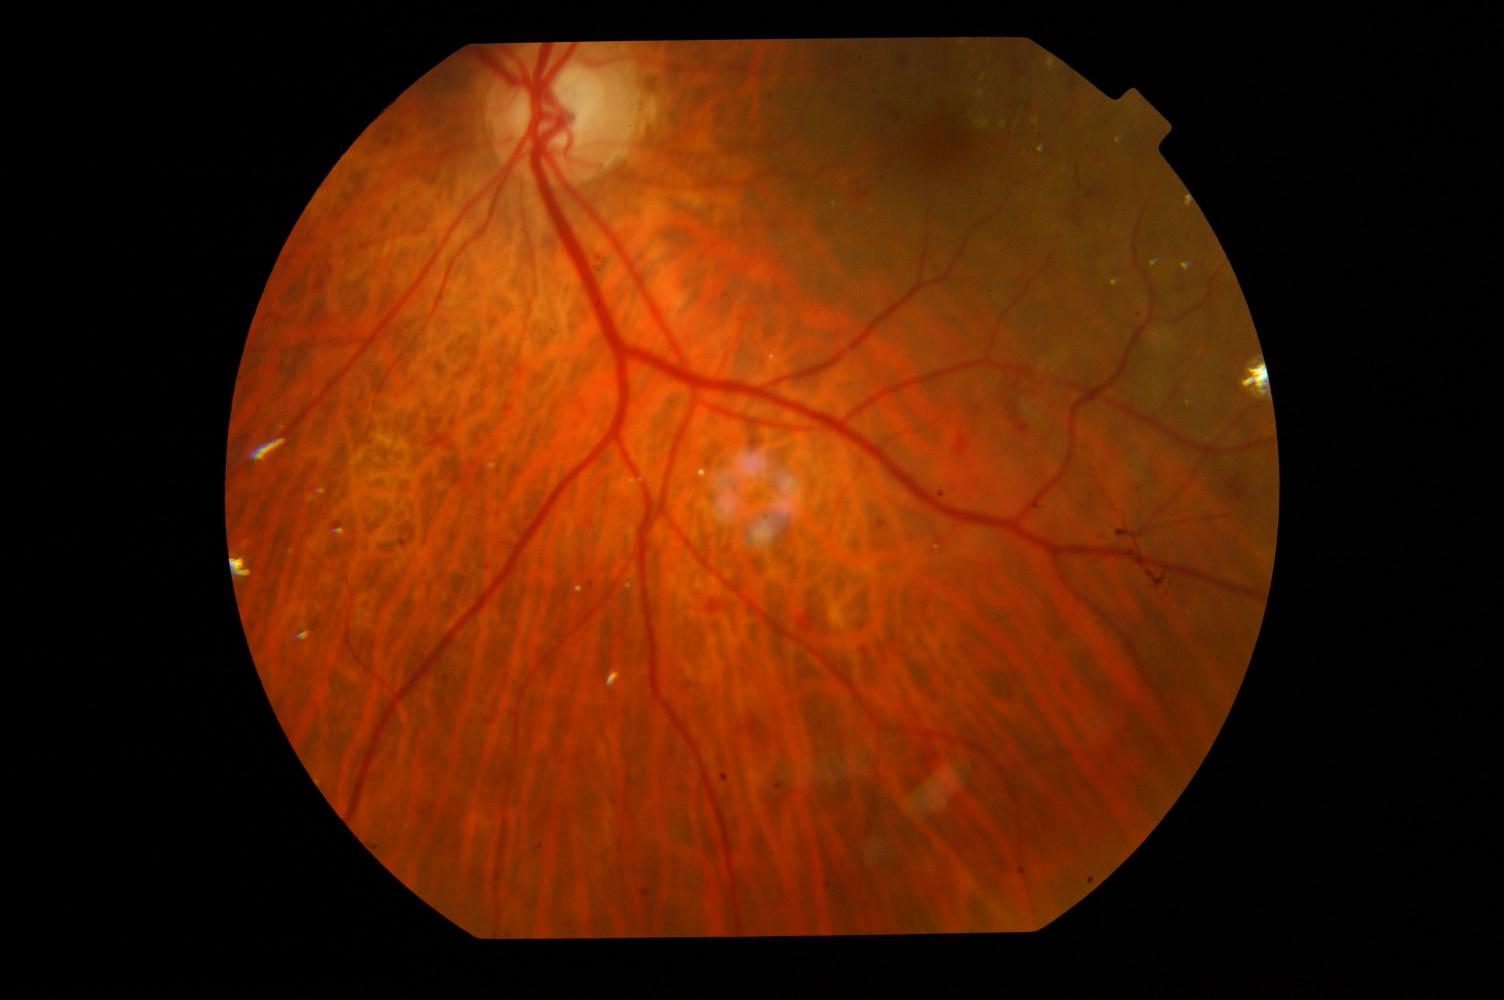 Diagnoses: diabetic retinopathy.